Retinal fundus photograph: 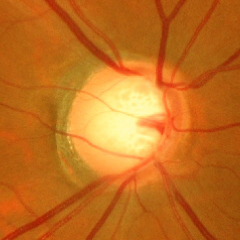 Glaucomatous changes are present. Showing advanced glaucoma.